848 x 848 pixels
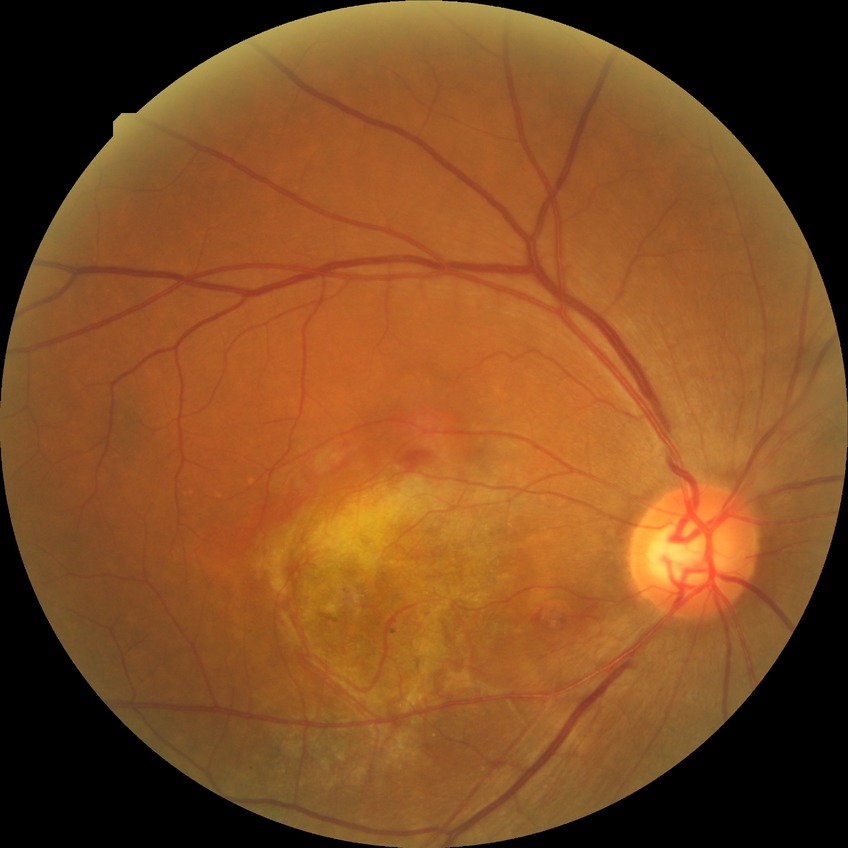 diabetic retinopathy (DR)@no diabetic retinopathy (NDR).